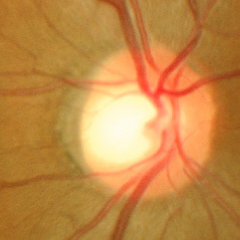 Glaucoma status = no glaucoma.